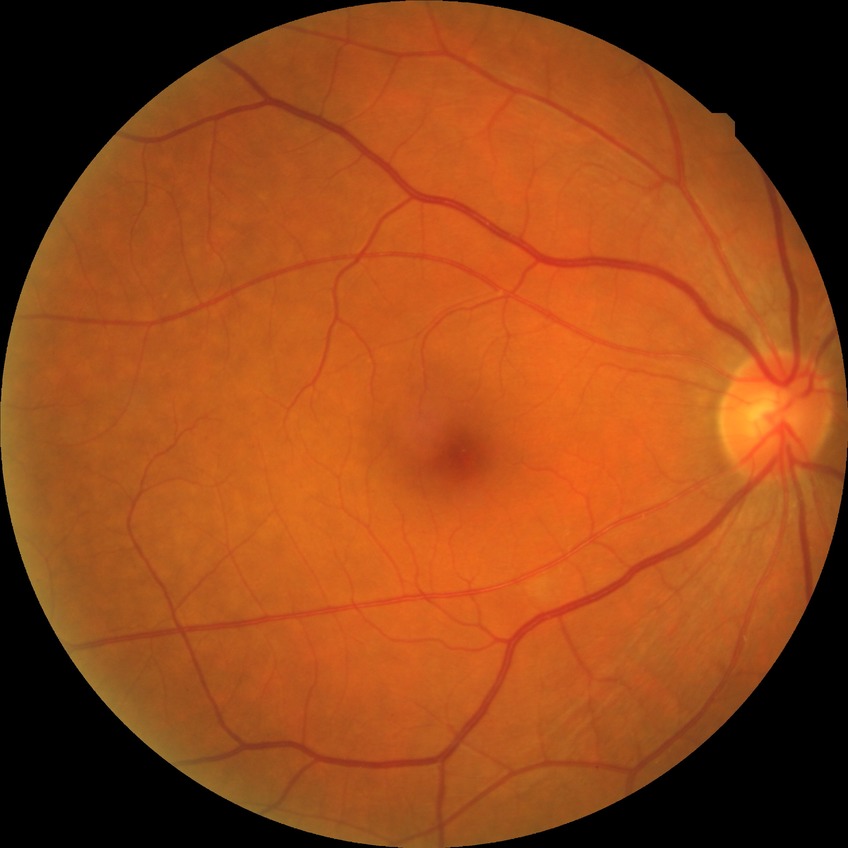
Diabetic retinopathy (DR): pre-proliferative diabetic retinopathy (PPDR).